Non-mydriatic acquisition · disc-centered field · Nidek AFC-330:
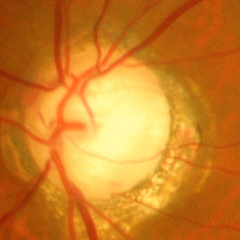
Glaucoma status: advanced glaucoma.